Wide-field fundus photograph from neonatal ROP screening · camera: Clarity RetCam 3 (130° FOV) · 640 x 480 pixels:
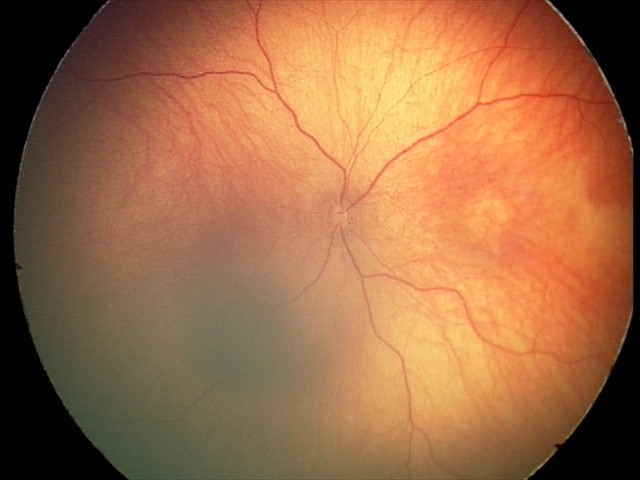
Screening series with optic nerve hypoplasia.